No pharmacologic dilation — 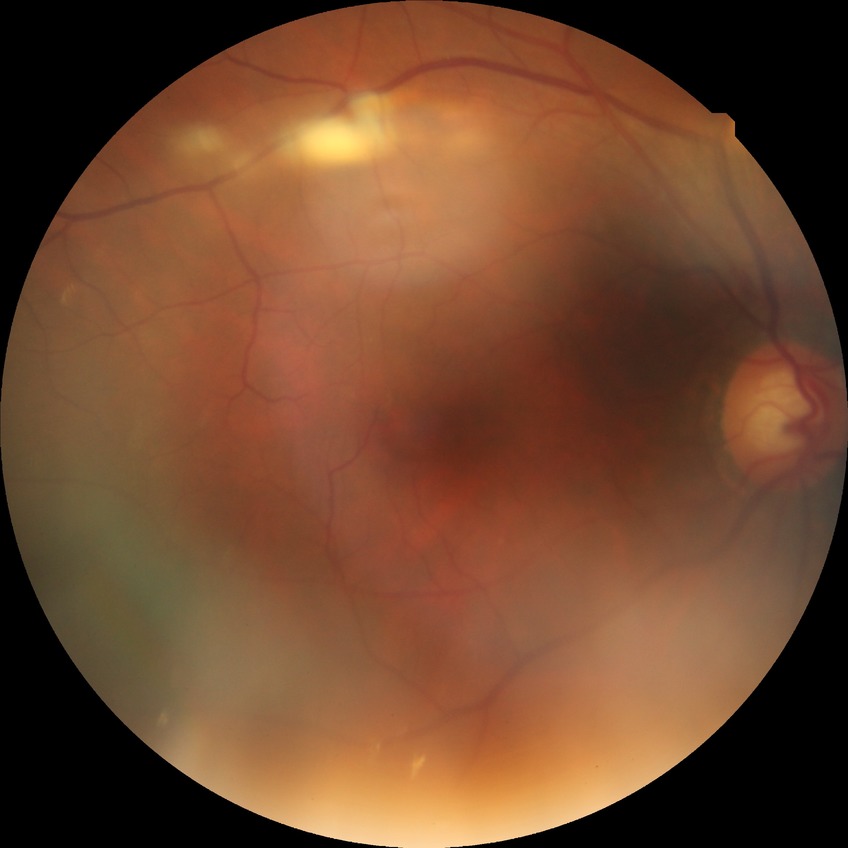 Annotations:
– diabetic retinopathy (DR) — NDR (no diabetic retinopathy)